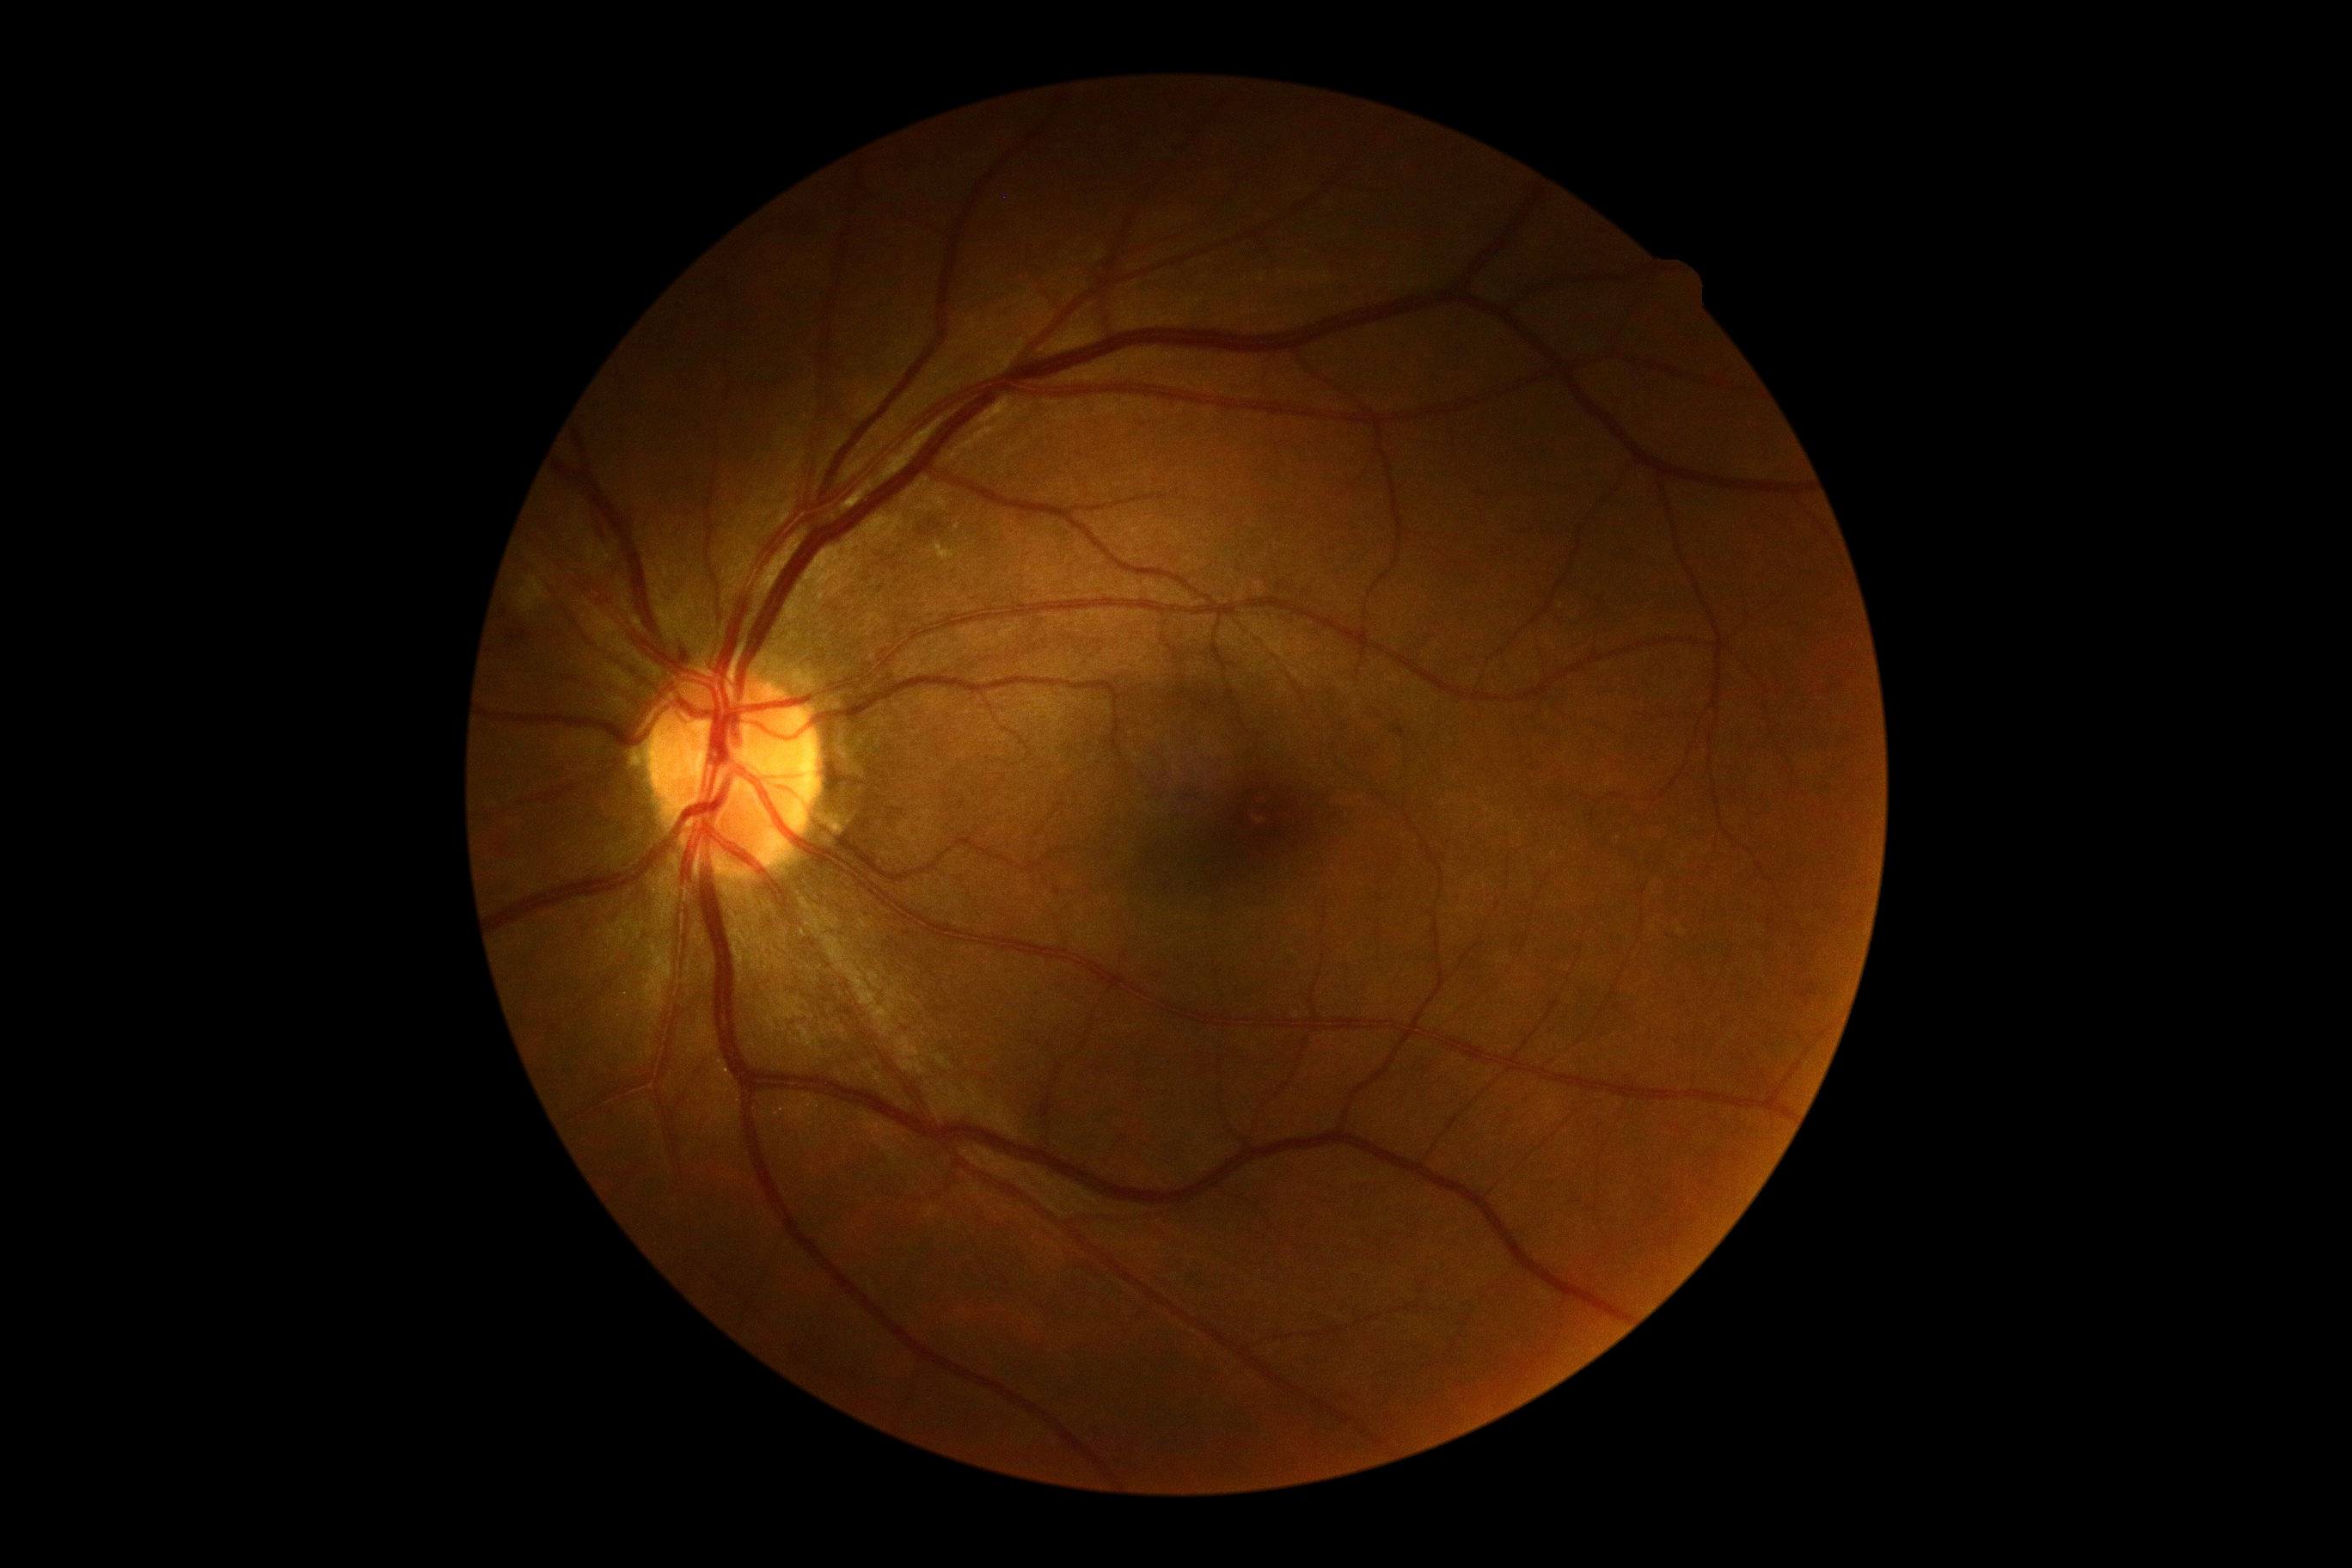 The retinopathy is classified as non-proliferative diabetic retinopathy.
Retinopathy: grade 2.